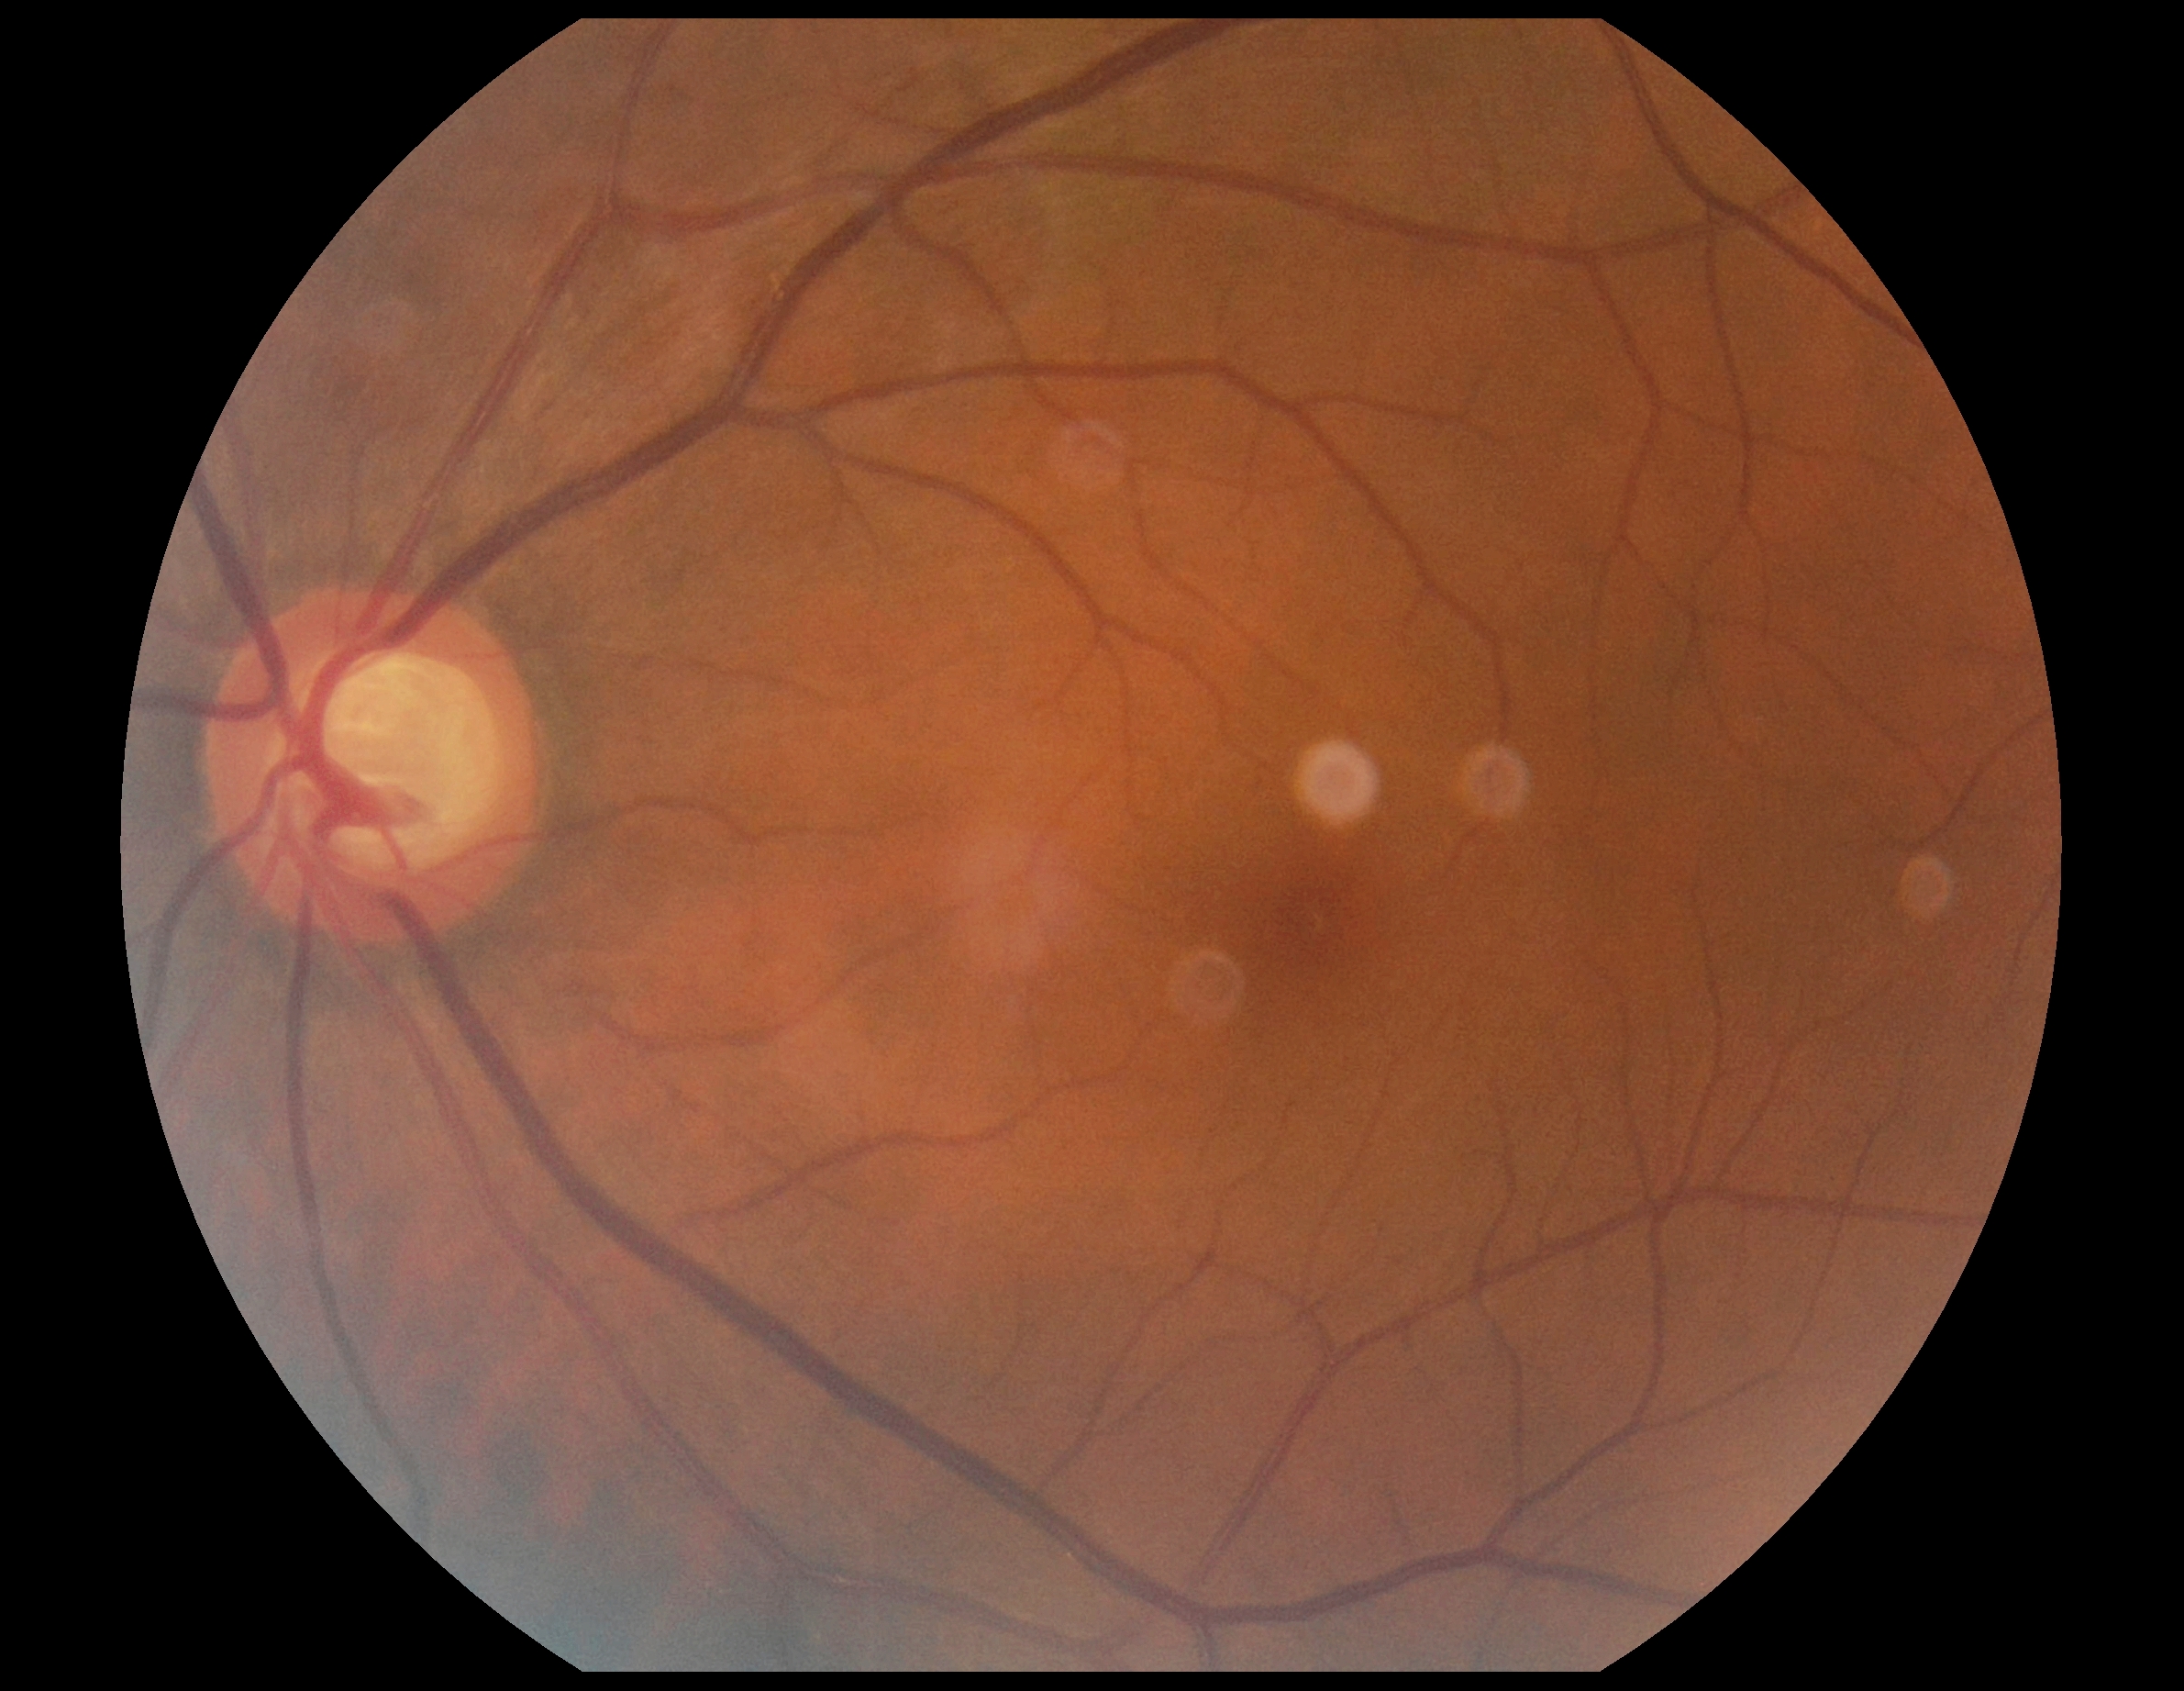 {
  "dr_grade": "grade 0 (no apparent retinopathy)"
}